45-degree field of view:
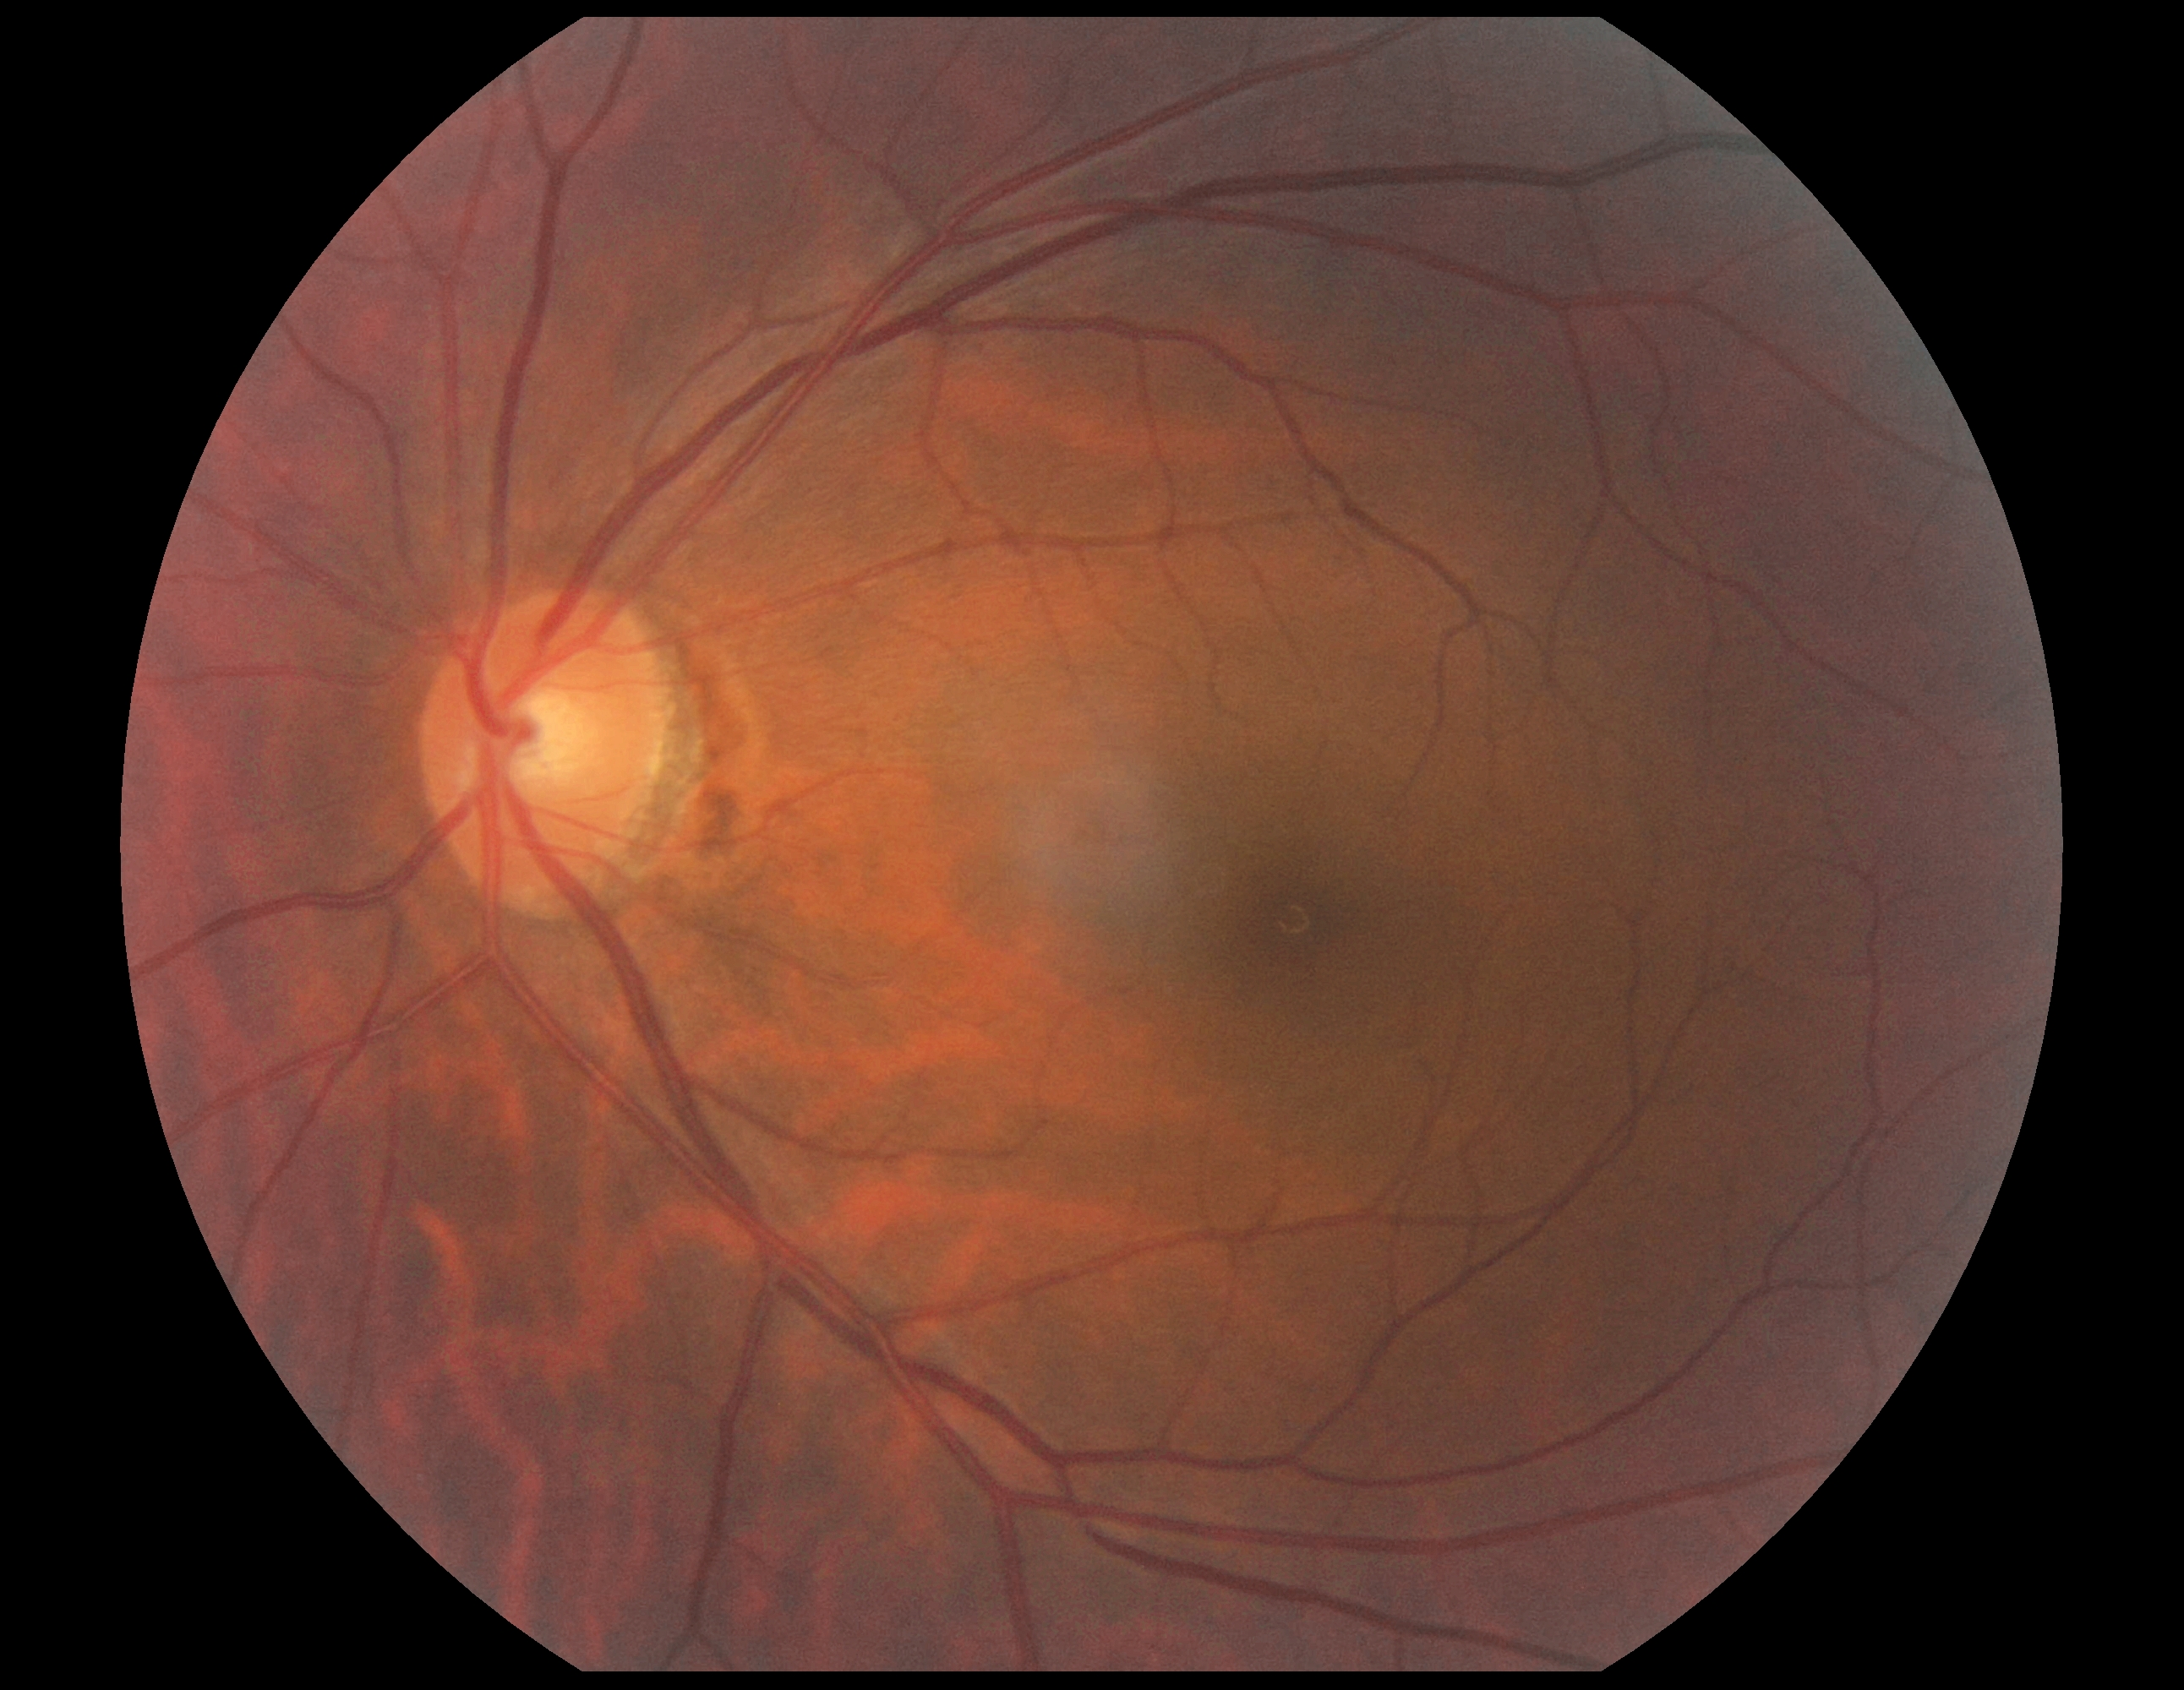 Diabetic retinopathy severity is grade 0.